Fundus photo, 45° field of view.
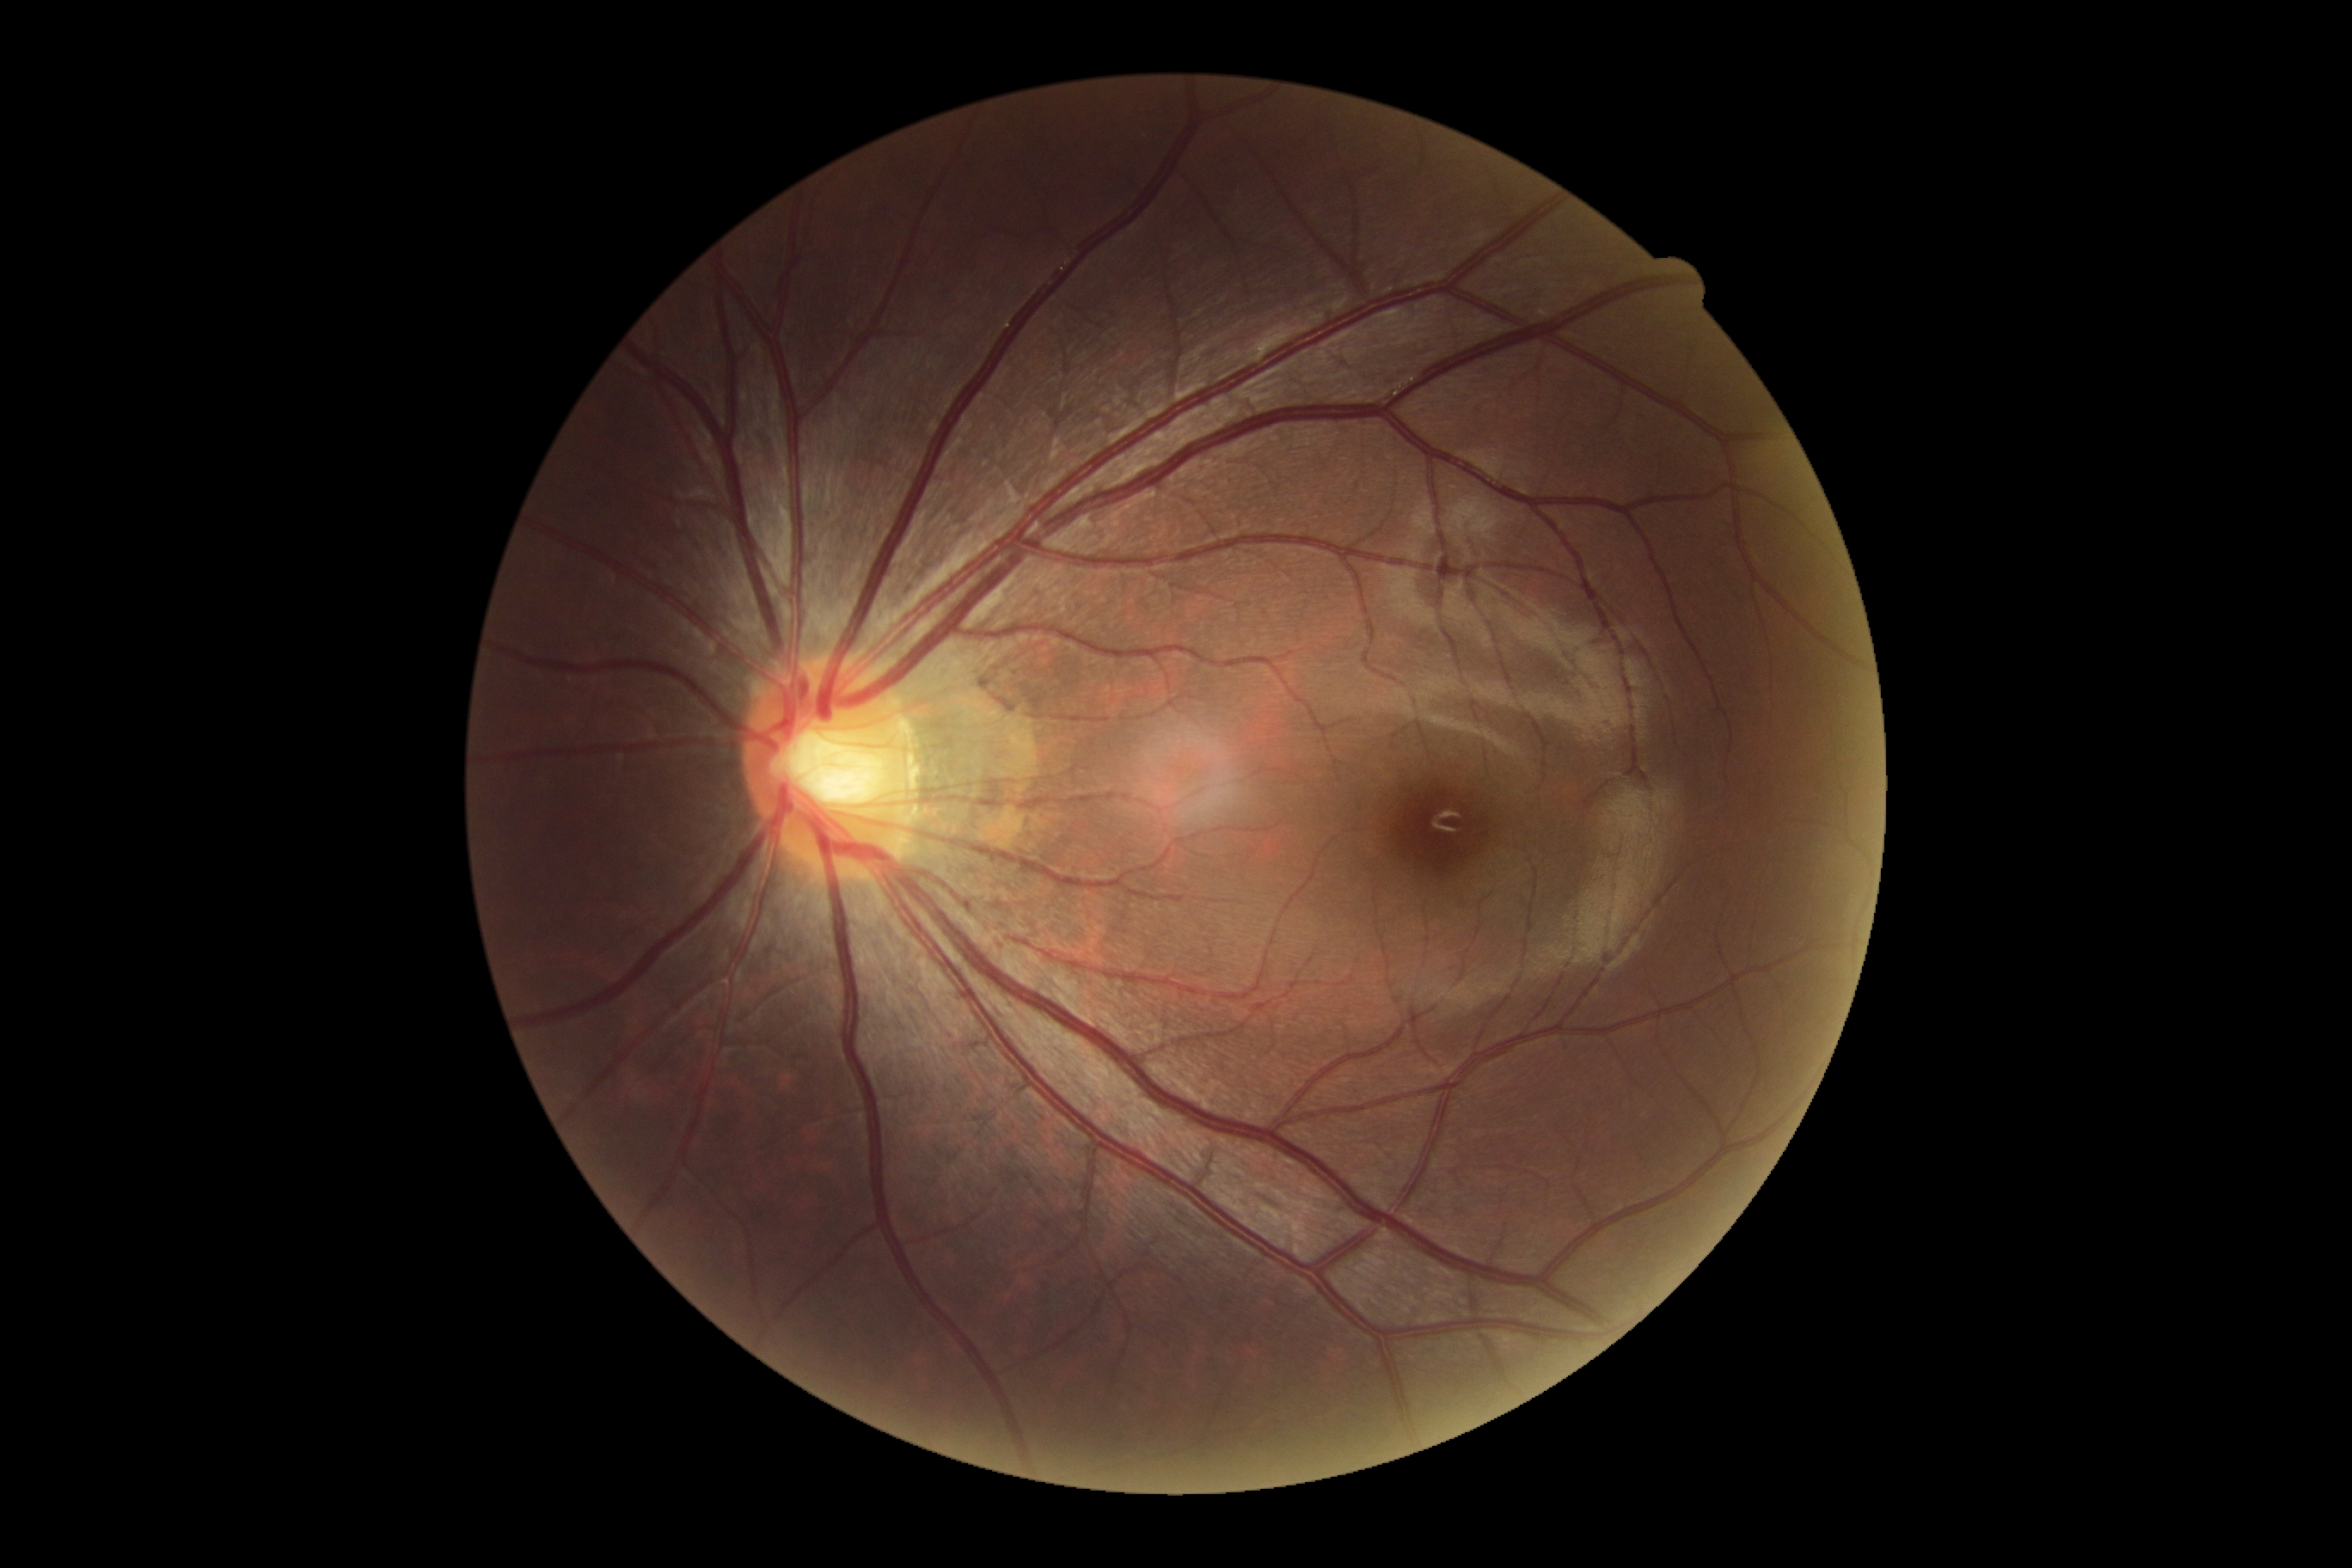

diabetic retinopathy grade: 0/4.